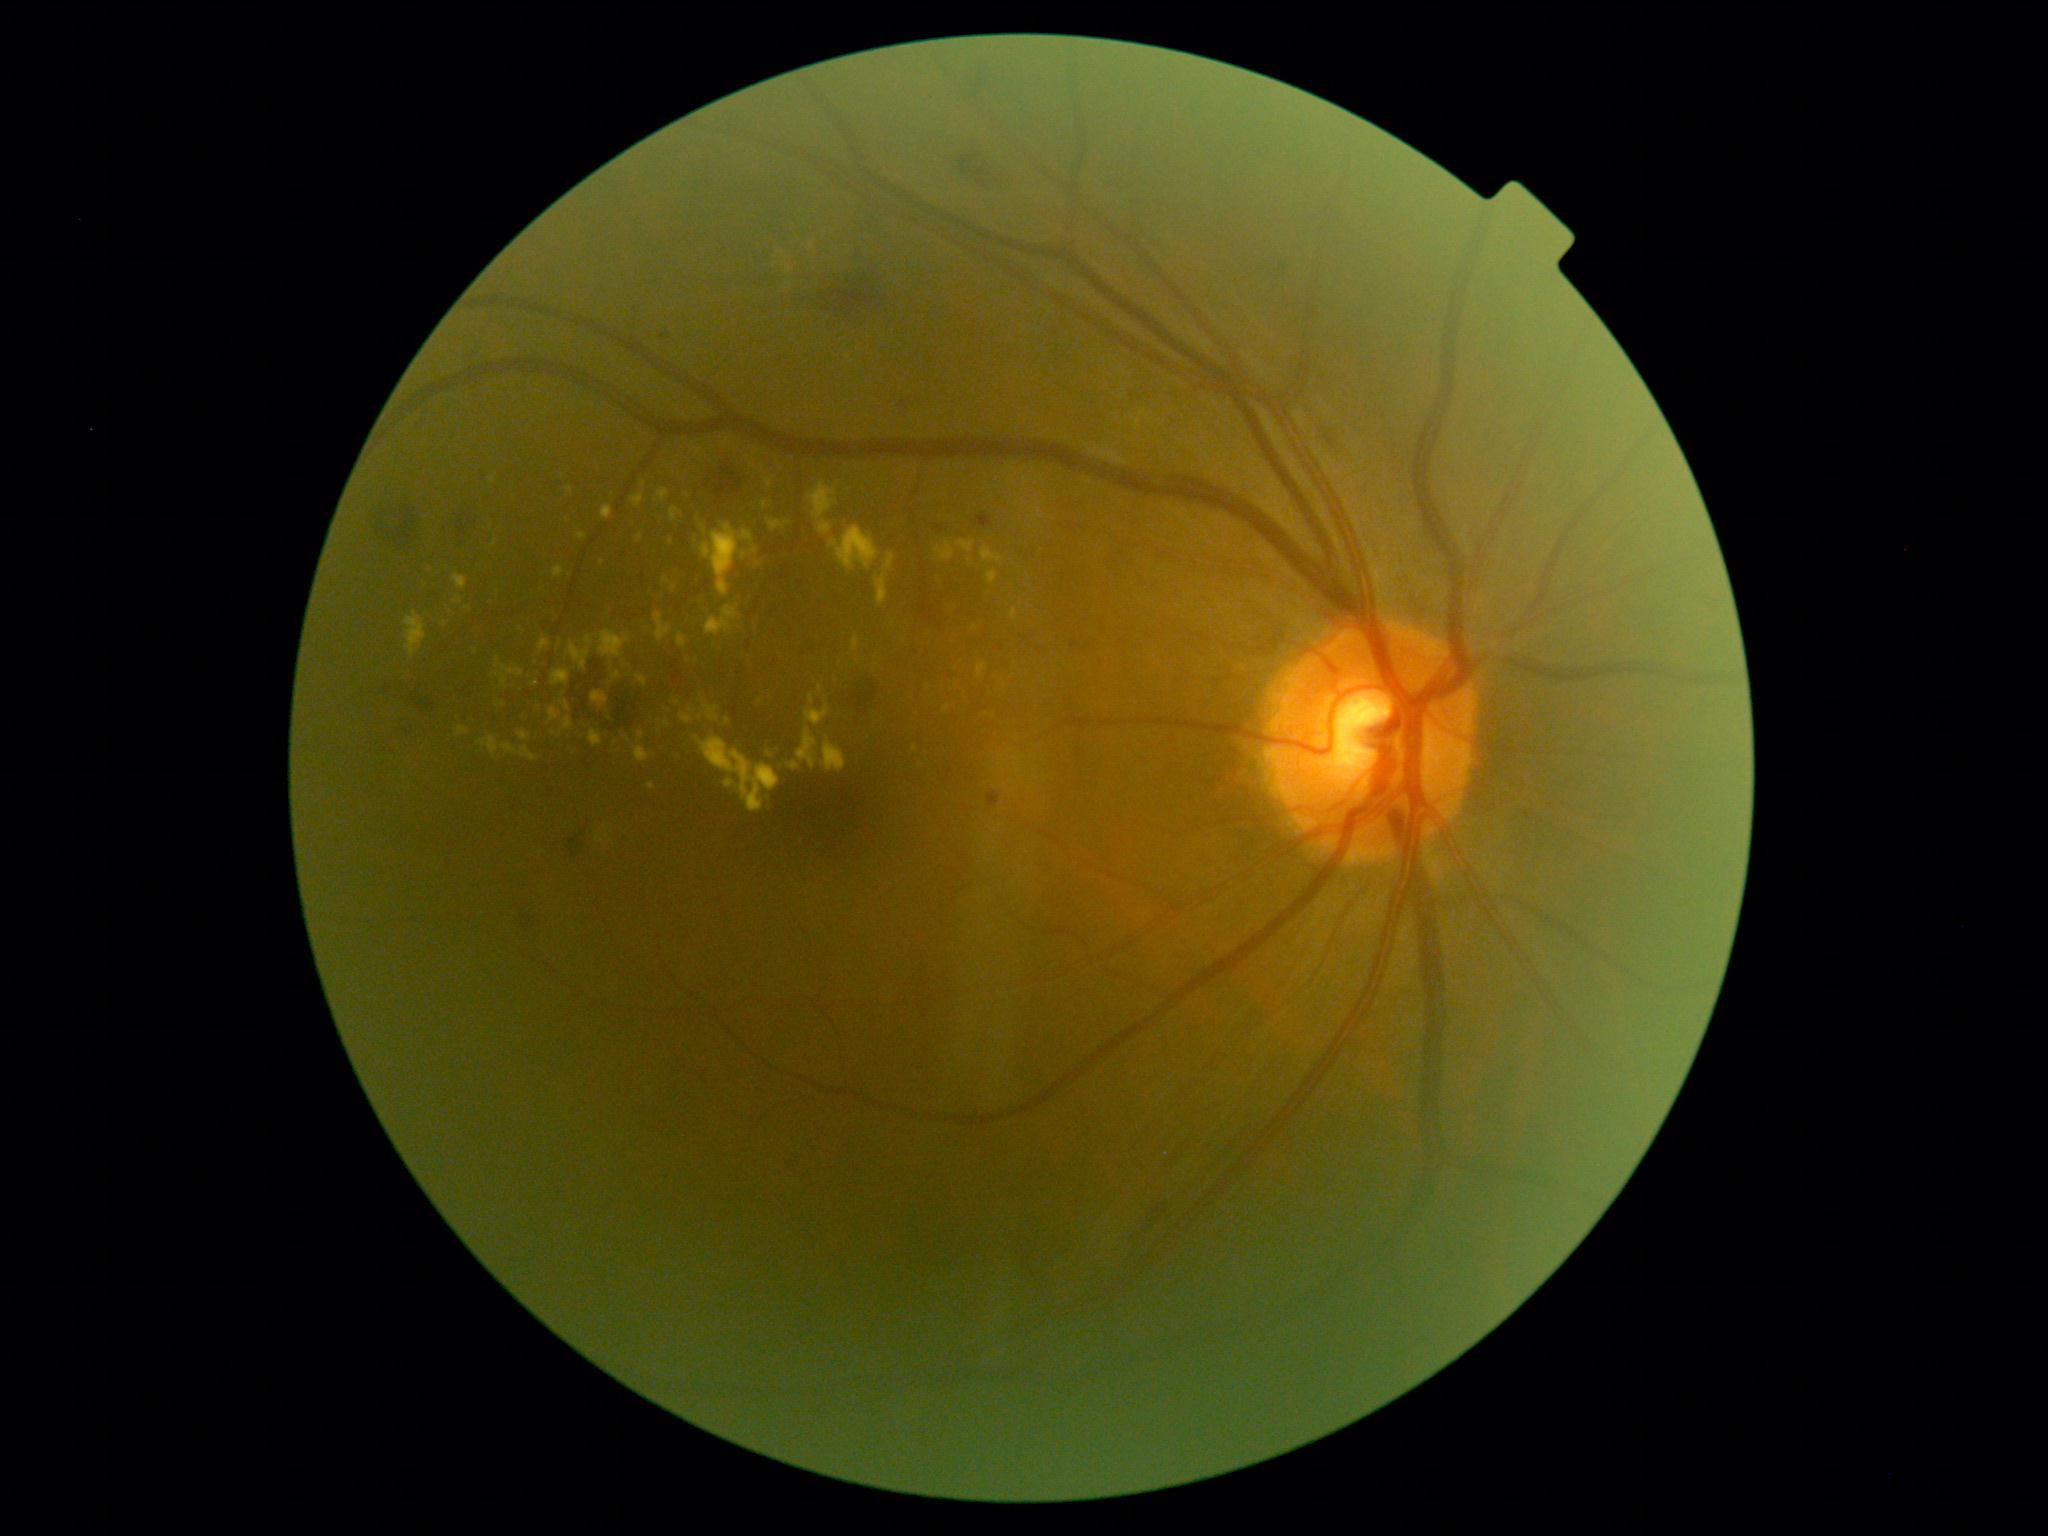
<lesions partial="true">
  <dr_grade>2</dr_grade>
  <ex partial="true">region(851, 635, 861, 653) | region(821, 737, 847, 773) | region(988, 571, 998, 585) | region(805, 706, 830, 727) | region(519, 730, 531, 742) | region(830, 526, 880, 571) | region(592, 691, 609, 709) | region(577, 534, 589, 541) | region(818, 686, 824, 696) | region(662, 577, 678, 592)</ex>
  <ex_small_approx>536, 684 | 1027, 482 | 496, 675 | 947, 709 | 671, 542 | 971, 563 | 679, 702</ex_small_approx>
</lesions>